Macula-centered; captured after pupil dilation; camera: Kowa VX-10α; 2361 x 1568 pixels; FOV: 50 degrees — 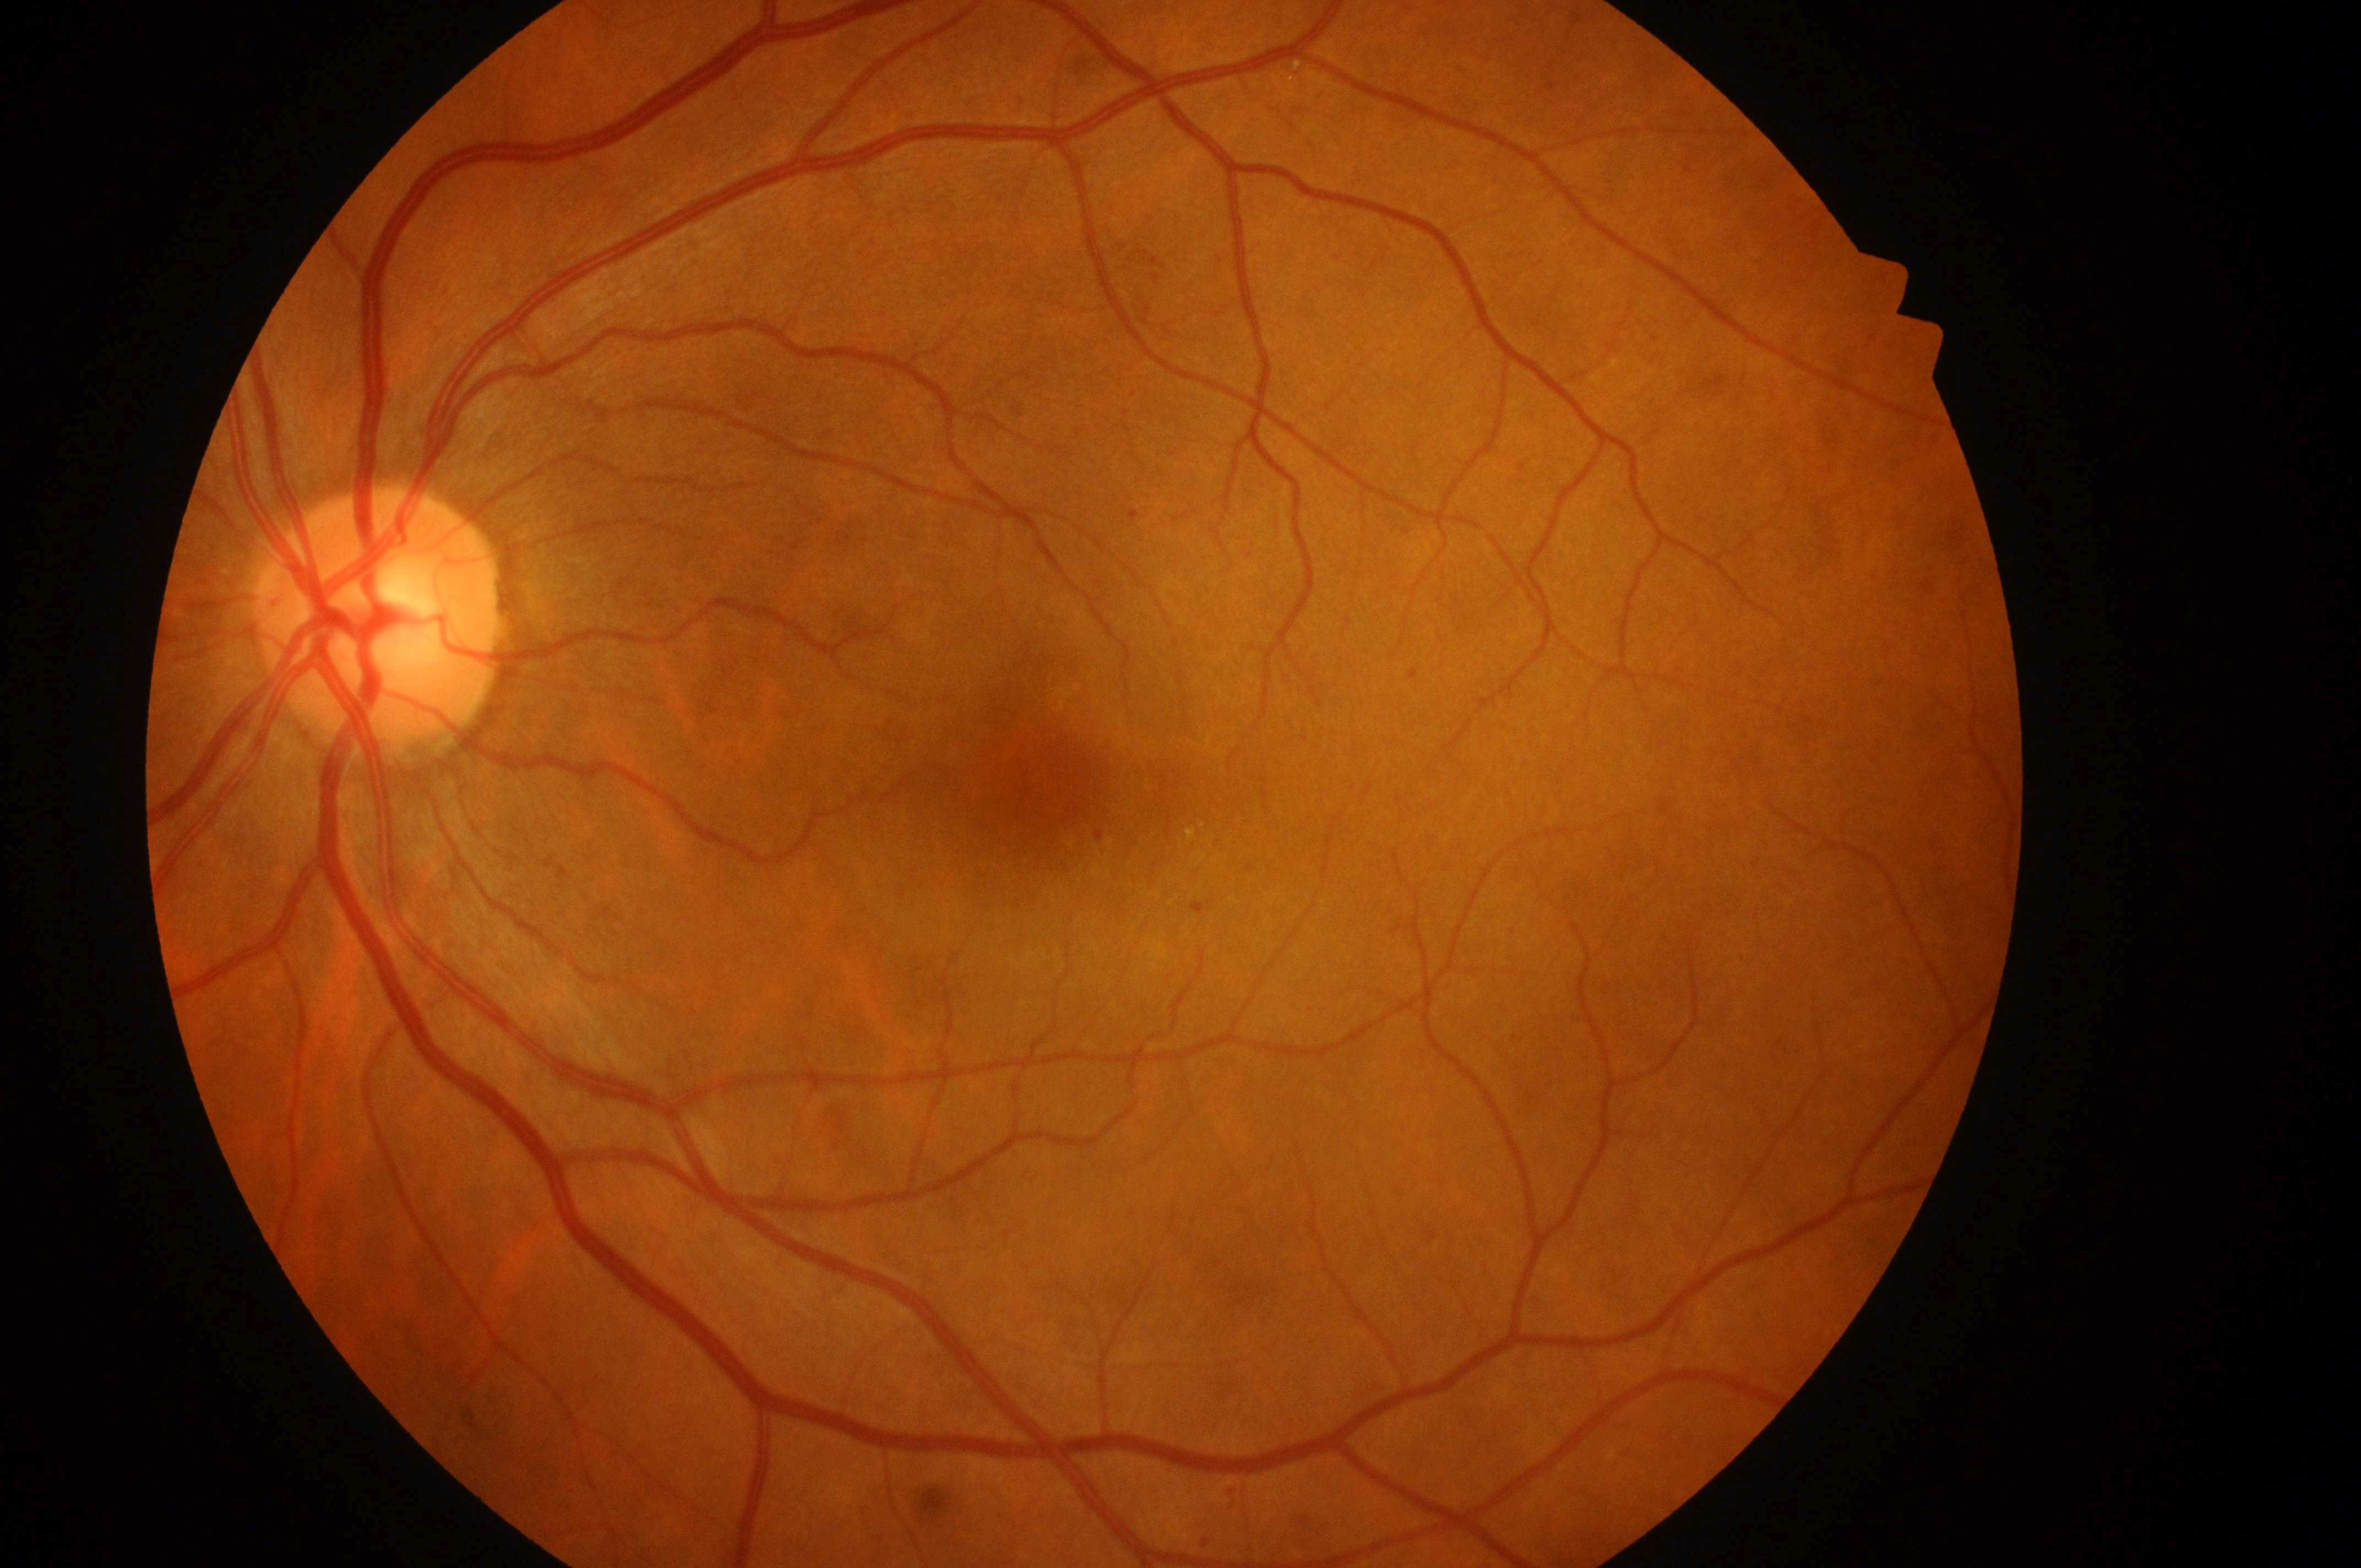 | field | value |
|---|---|
| DR class | non-proliferative diabetic retinopathy |
| DME | grade 2 (high risk) — hard exudates within one disc diameter of the macula center |
| optic nerve head | x=377, y=633 |
| laterality | left eye |
| DR grade | 2 (moderate NPDR) — more than just microaneurysms but less than severe NPDR |
| the fovea | x=1056, y=777 |